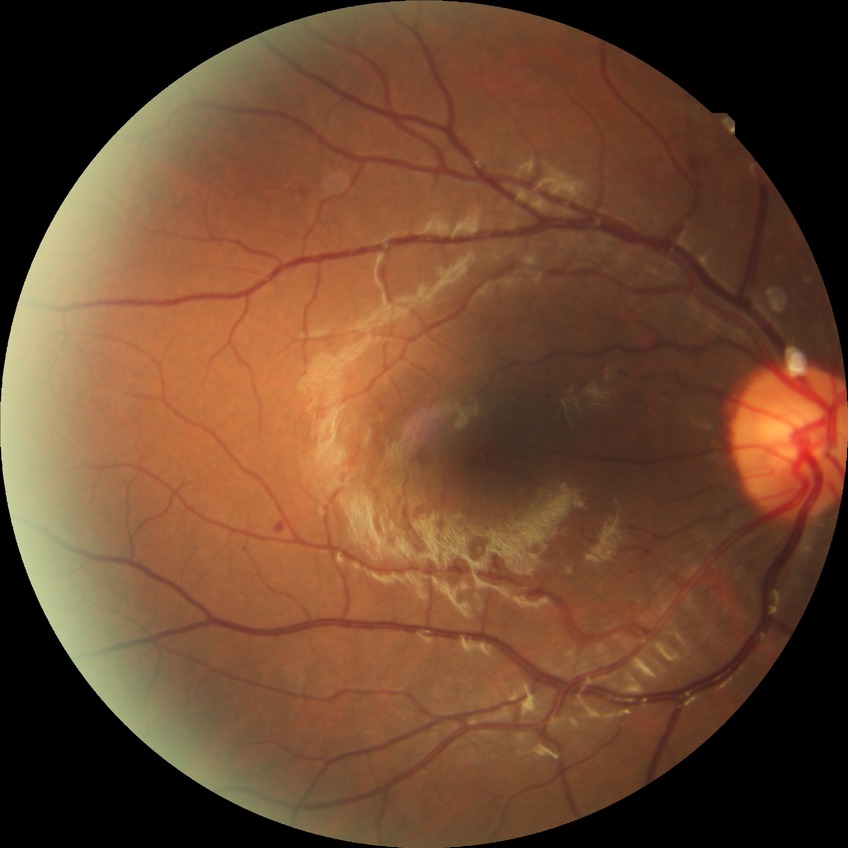

Annotations:
• modified Davis grading — simple diabetic retinopathy